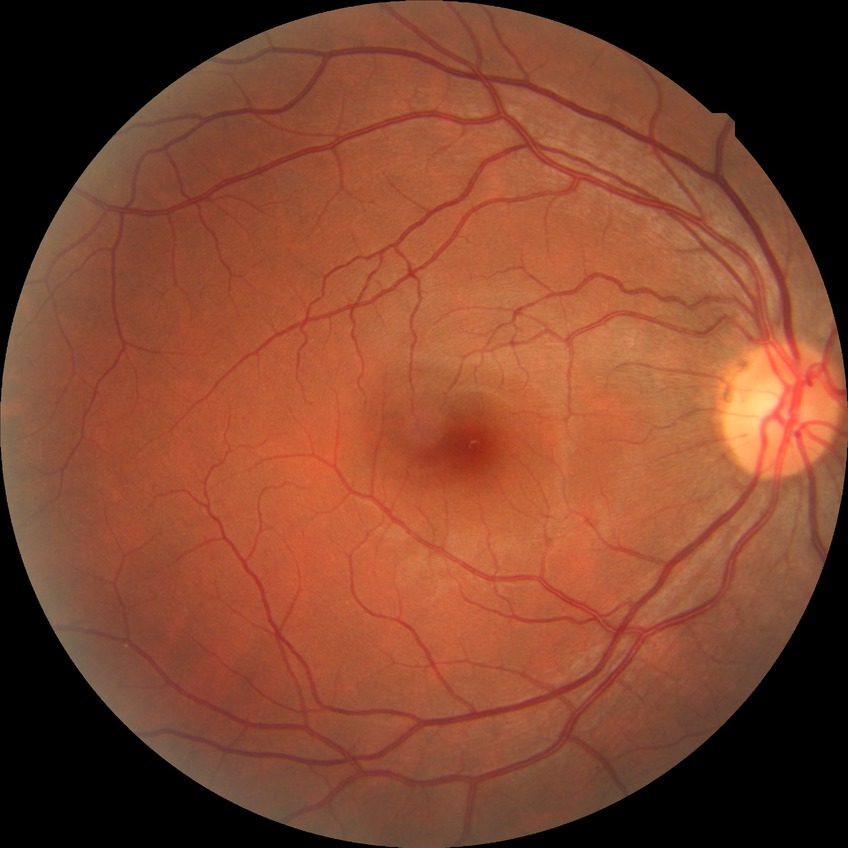 Modified Davis grading is no diabetic retinopathy.